Color fundus image: 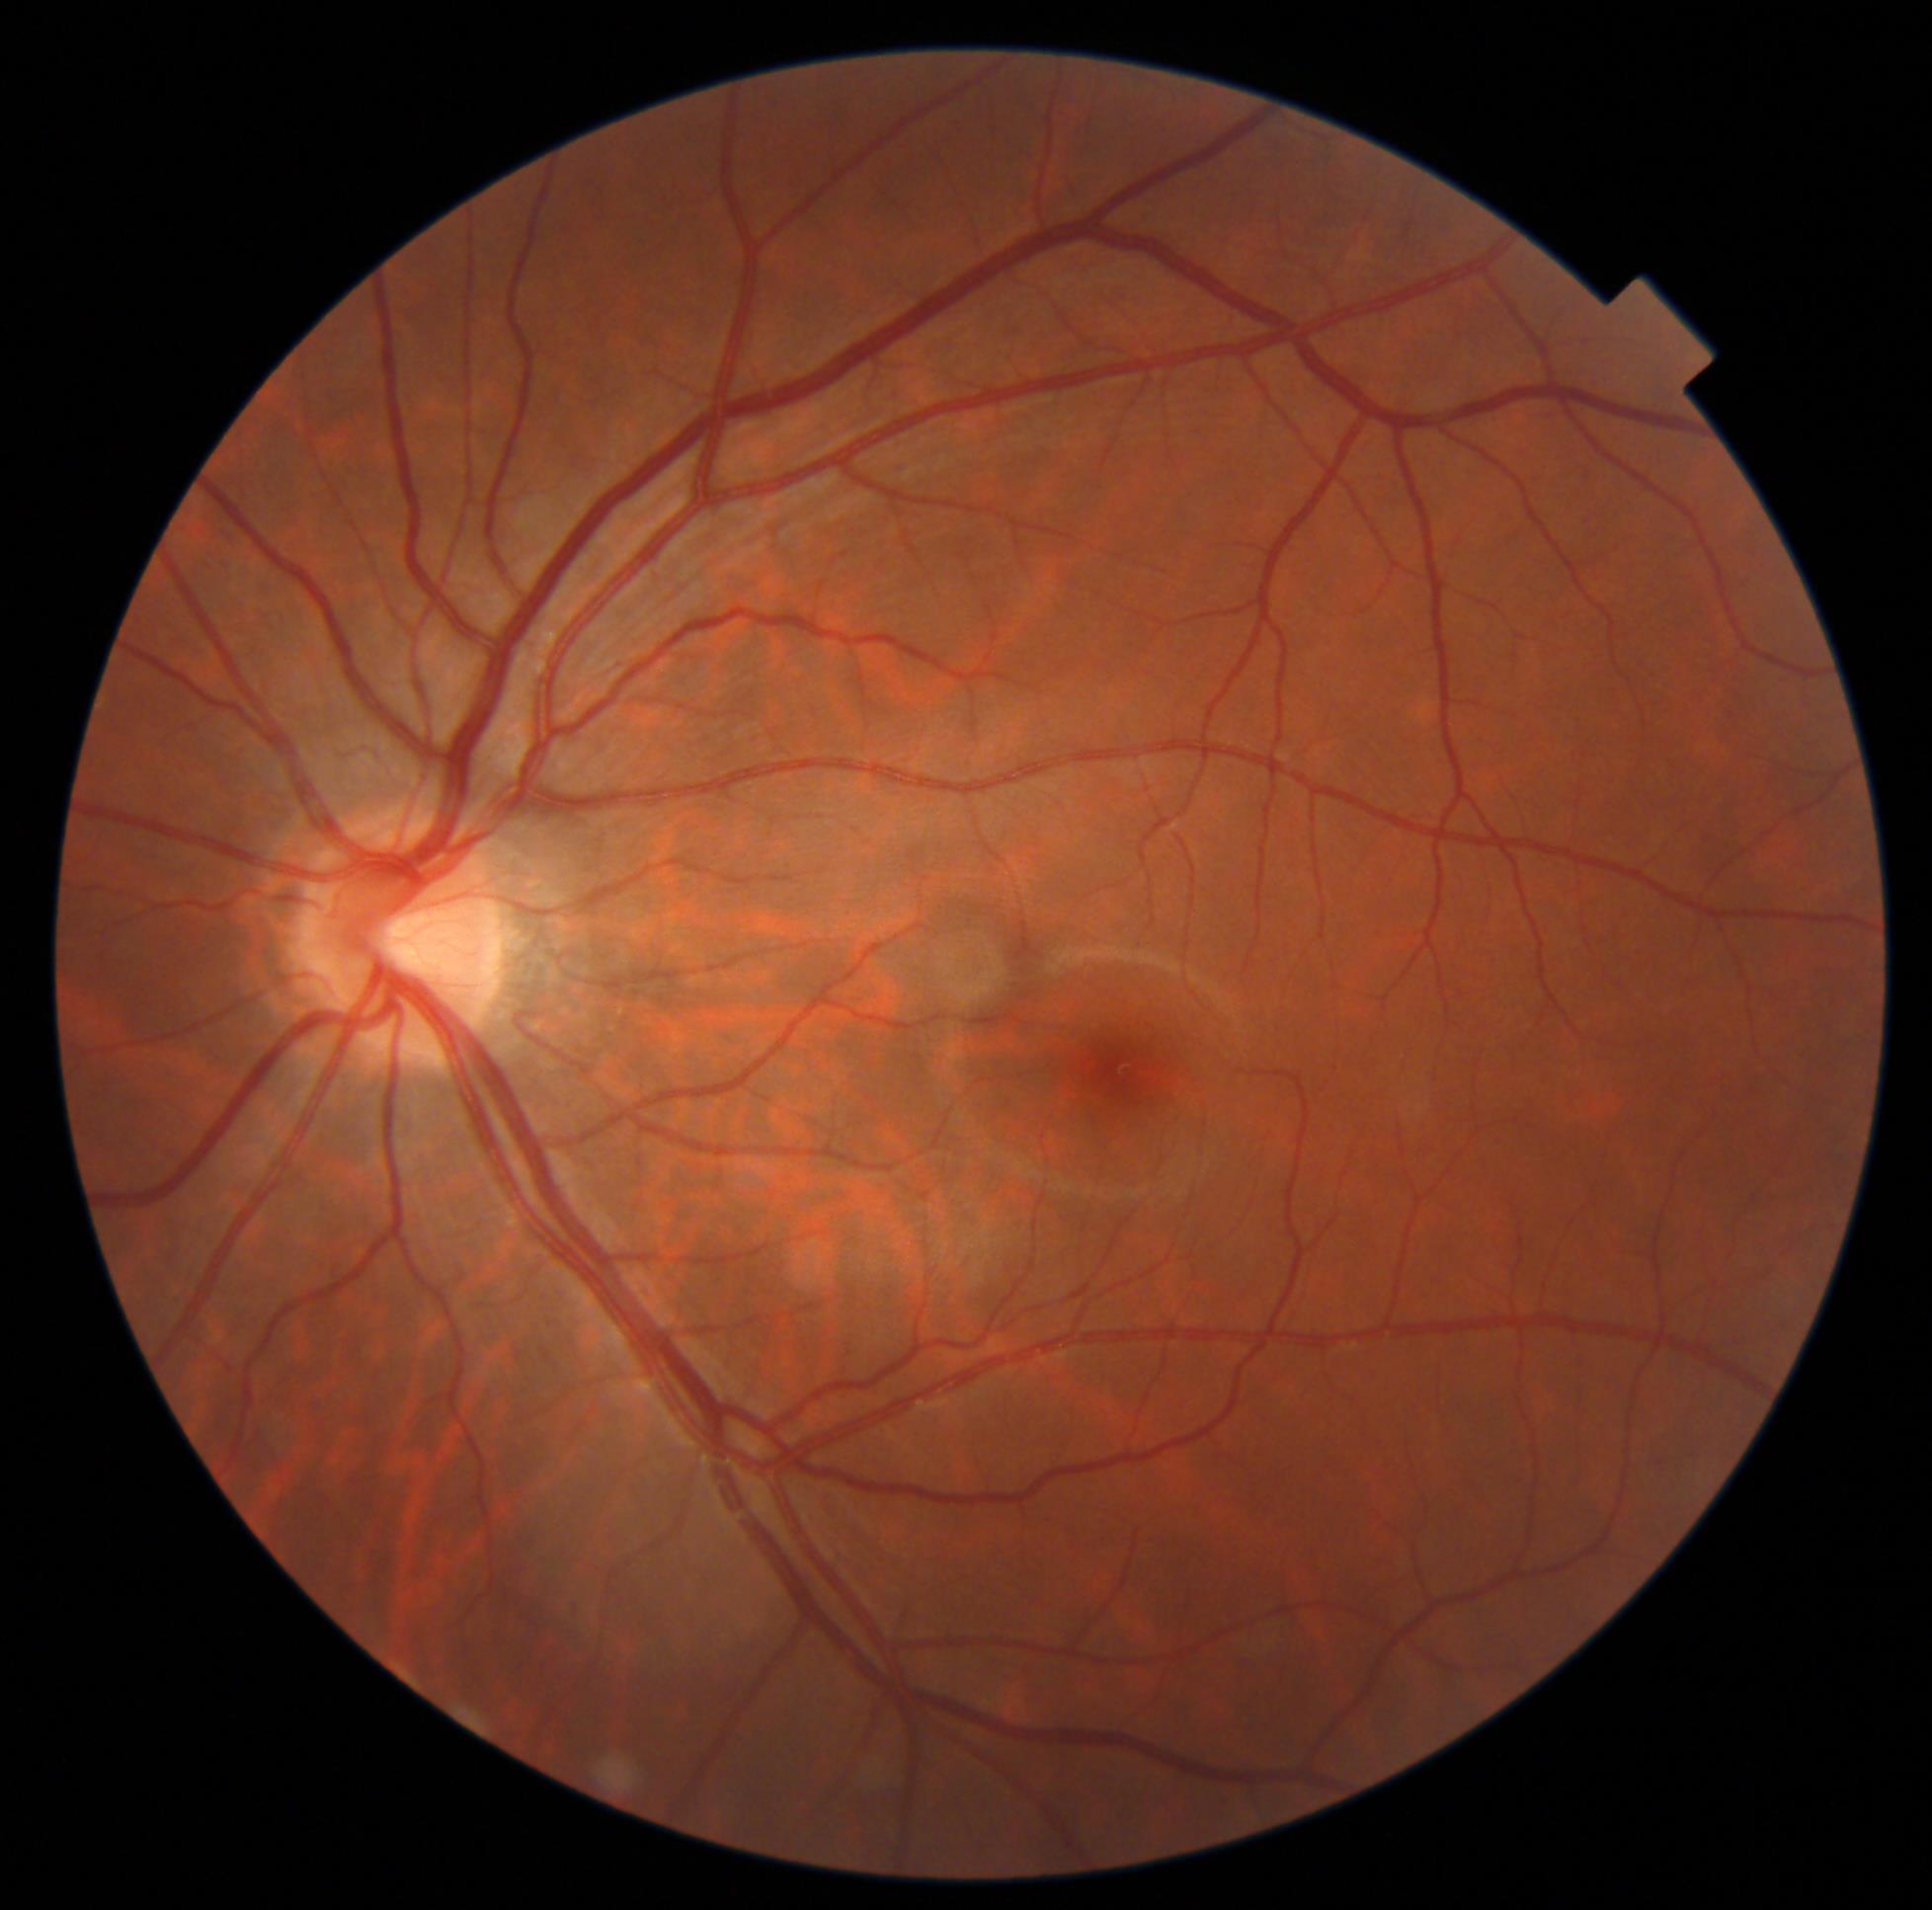

Diabetic retinopathy (DR) is 0 — no visible signs of diabetic retinopathy.